Phoenix ICON wide-field infant fundus image
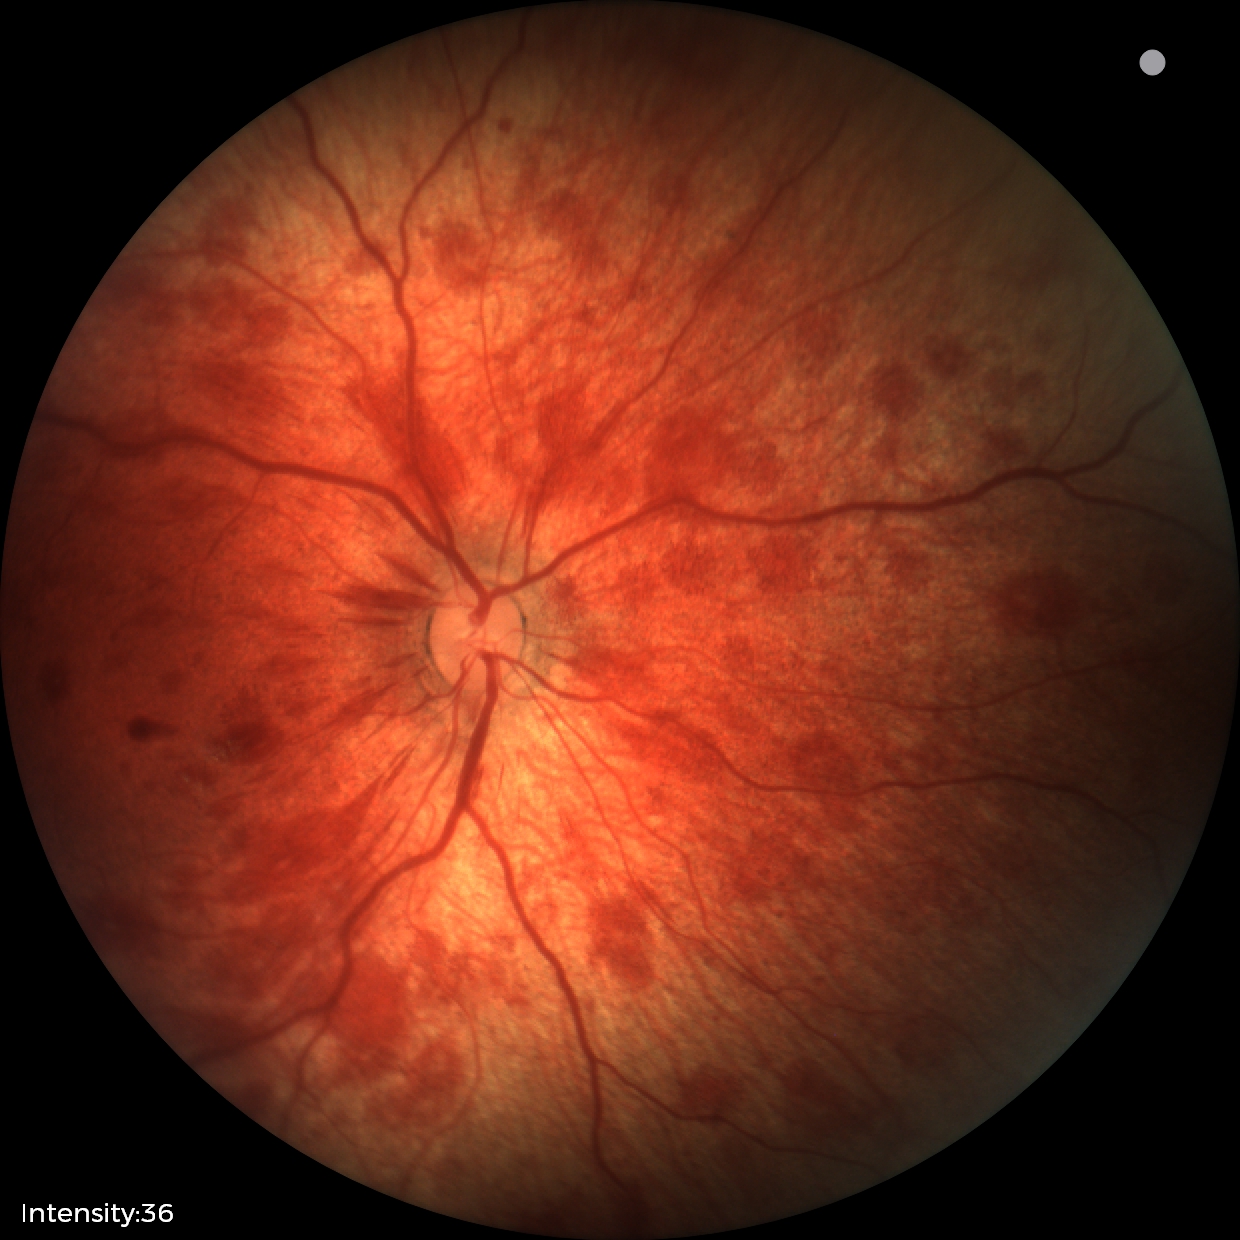 Diagnosis from this screening exam: retinal hemorrhages.